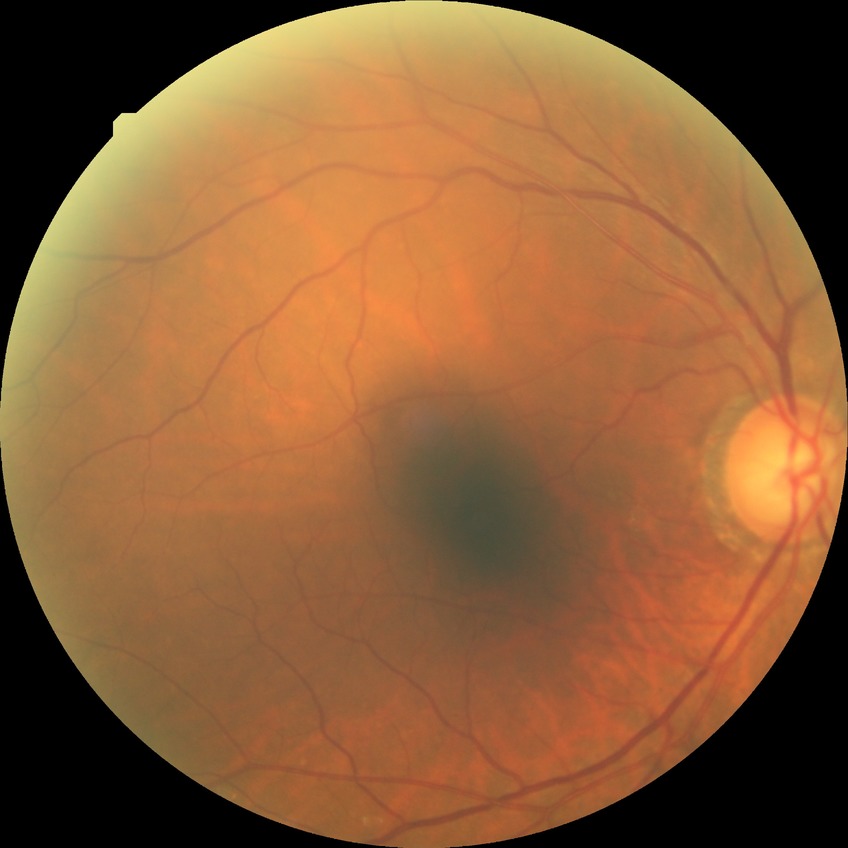
diabetic retinopathy (DR)@NDR (no diabetic retinopathy).